Pediatric retinal photograph (wide-field). 640 by 480 pixels: 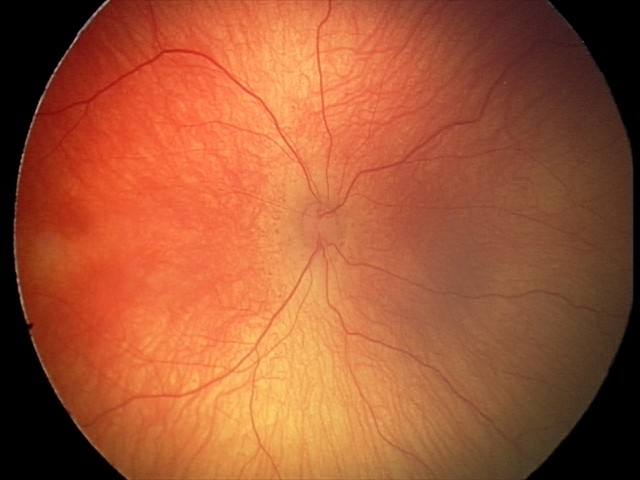

Screening examination consistent with retinopathy of prematurity stage 2.